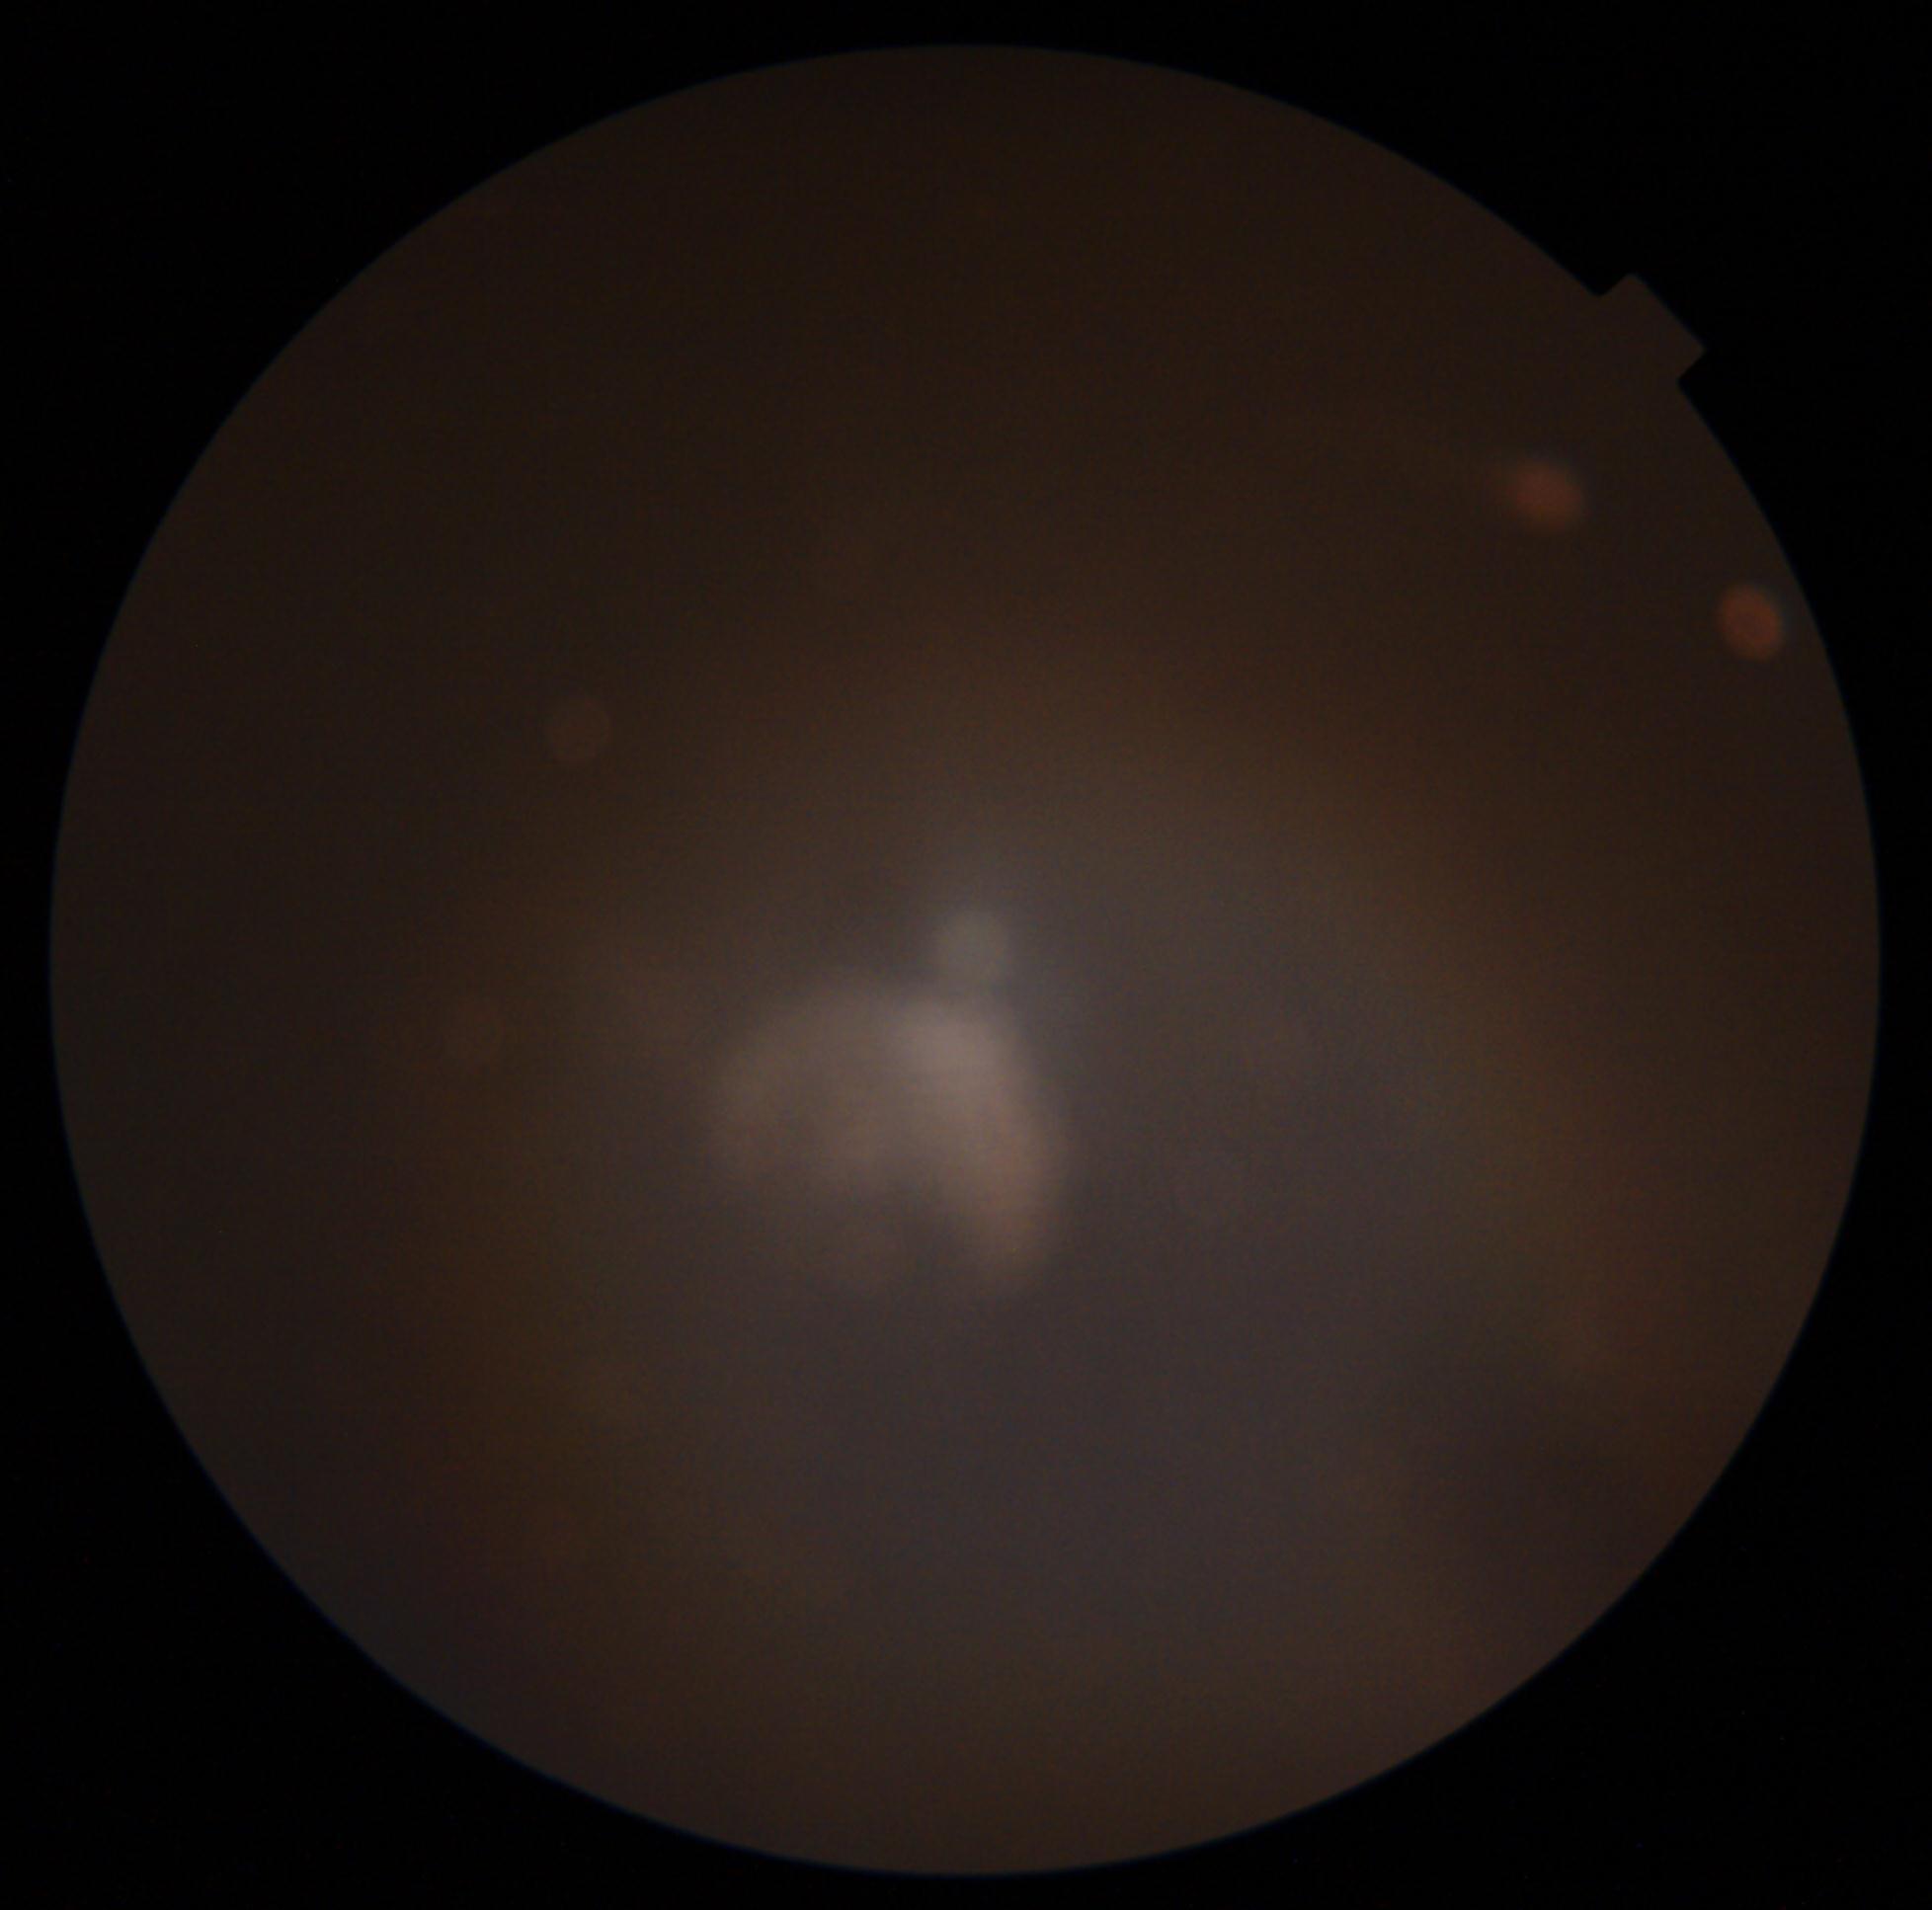
image quality@below grading threshold; diabetic retinopathy (DR)@ungradable due to poor image quality.